Tabletop color fundus camera image: 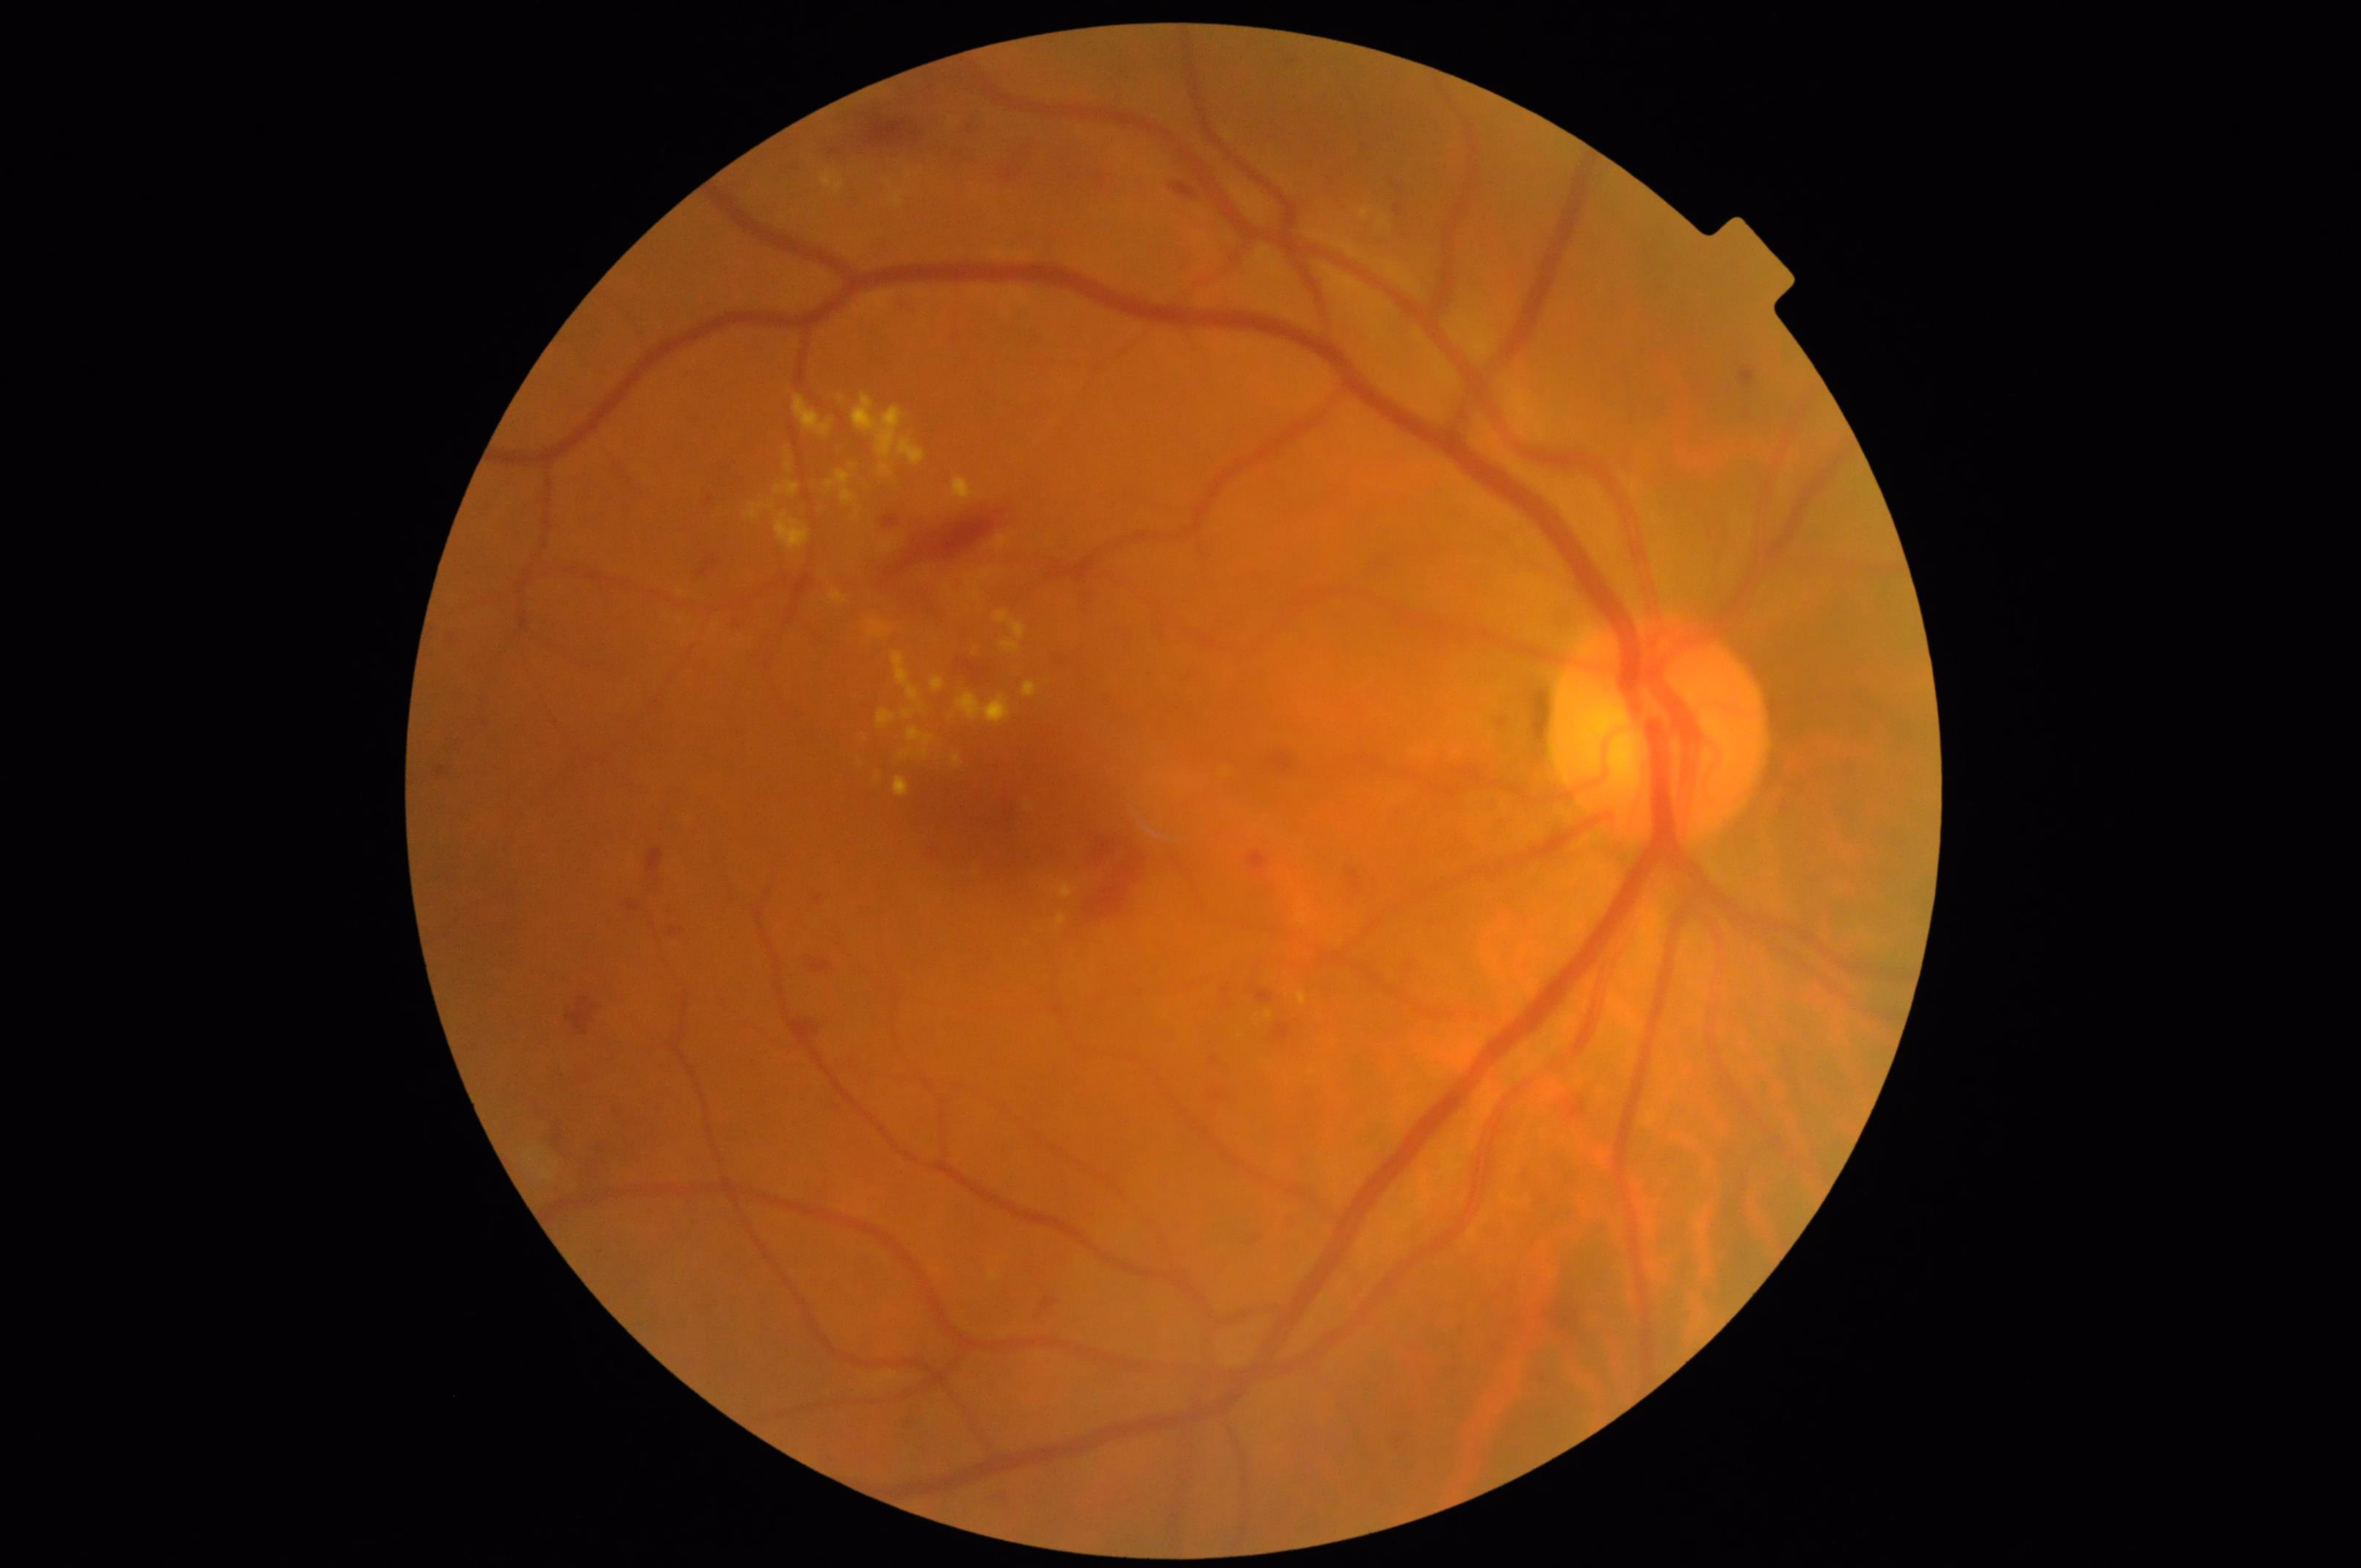

Overall = acceptable
Contrast = adequate